Camera: Phoenix ICON (100° FOV); pediatric retinal photograph (wide-field); image size 1240x1240.
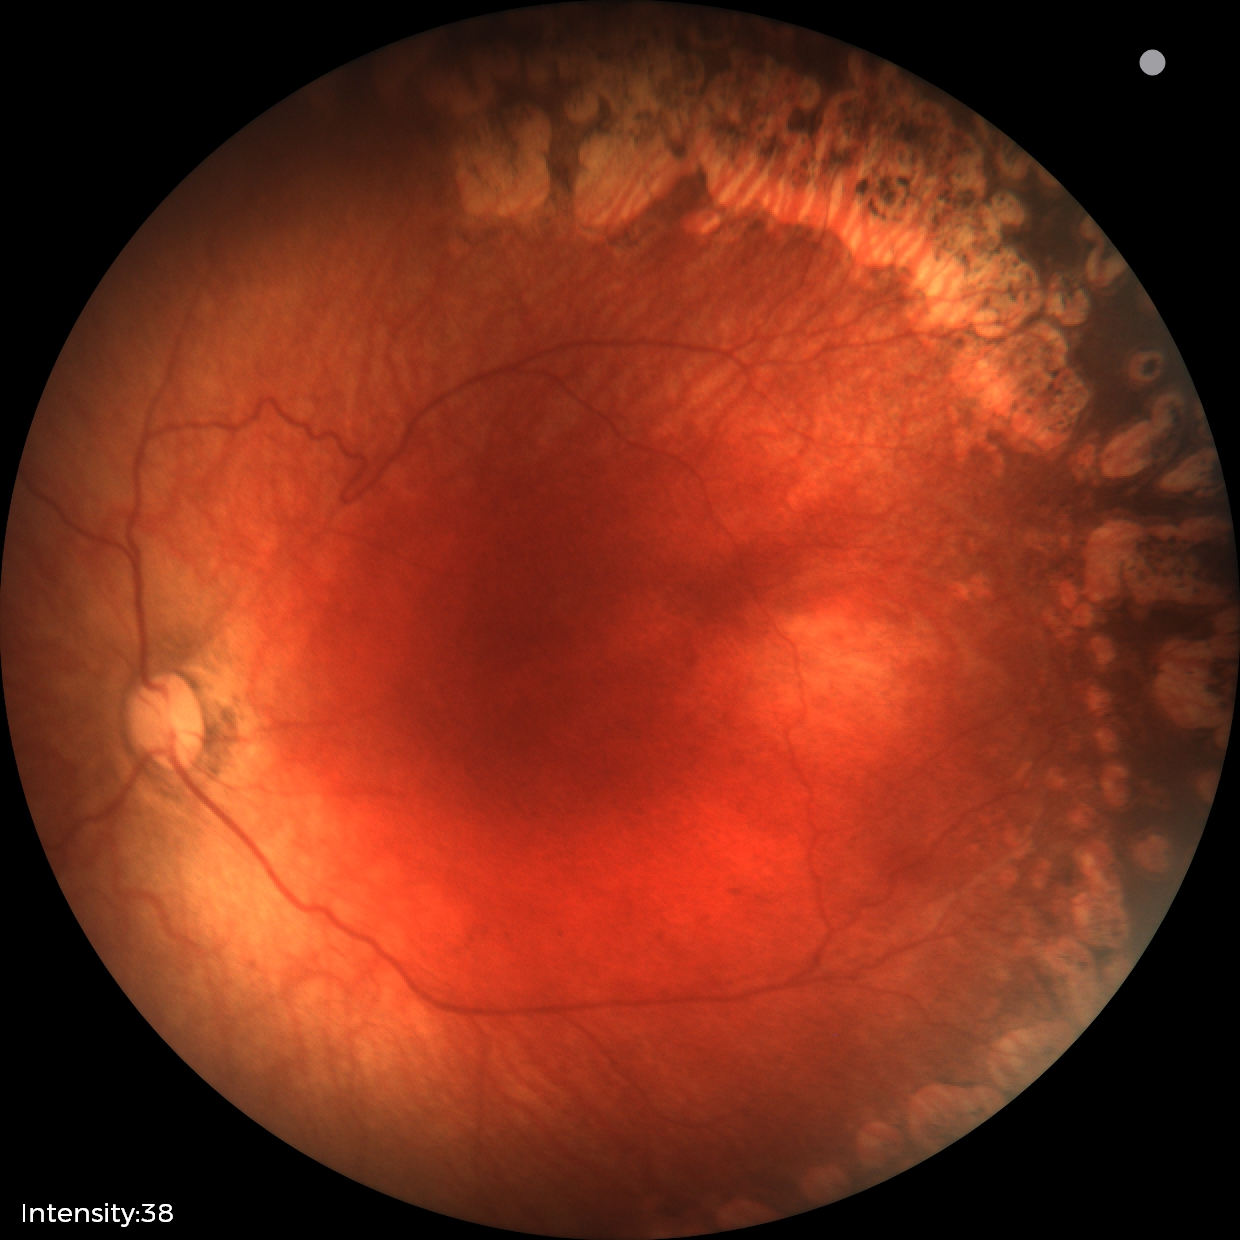

Without plus disease. Series diagnosed as status post retinopathy of prematurity.